45-degree field of view; 2212x1659.
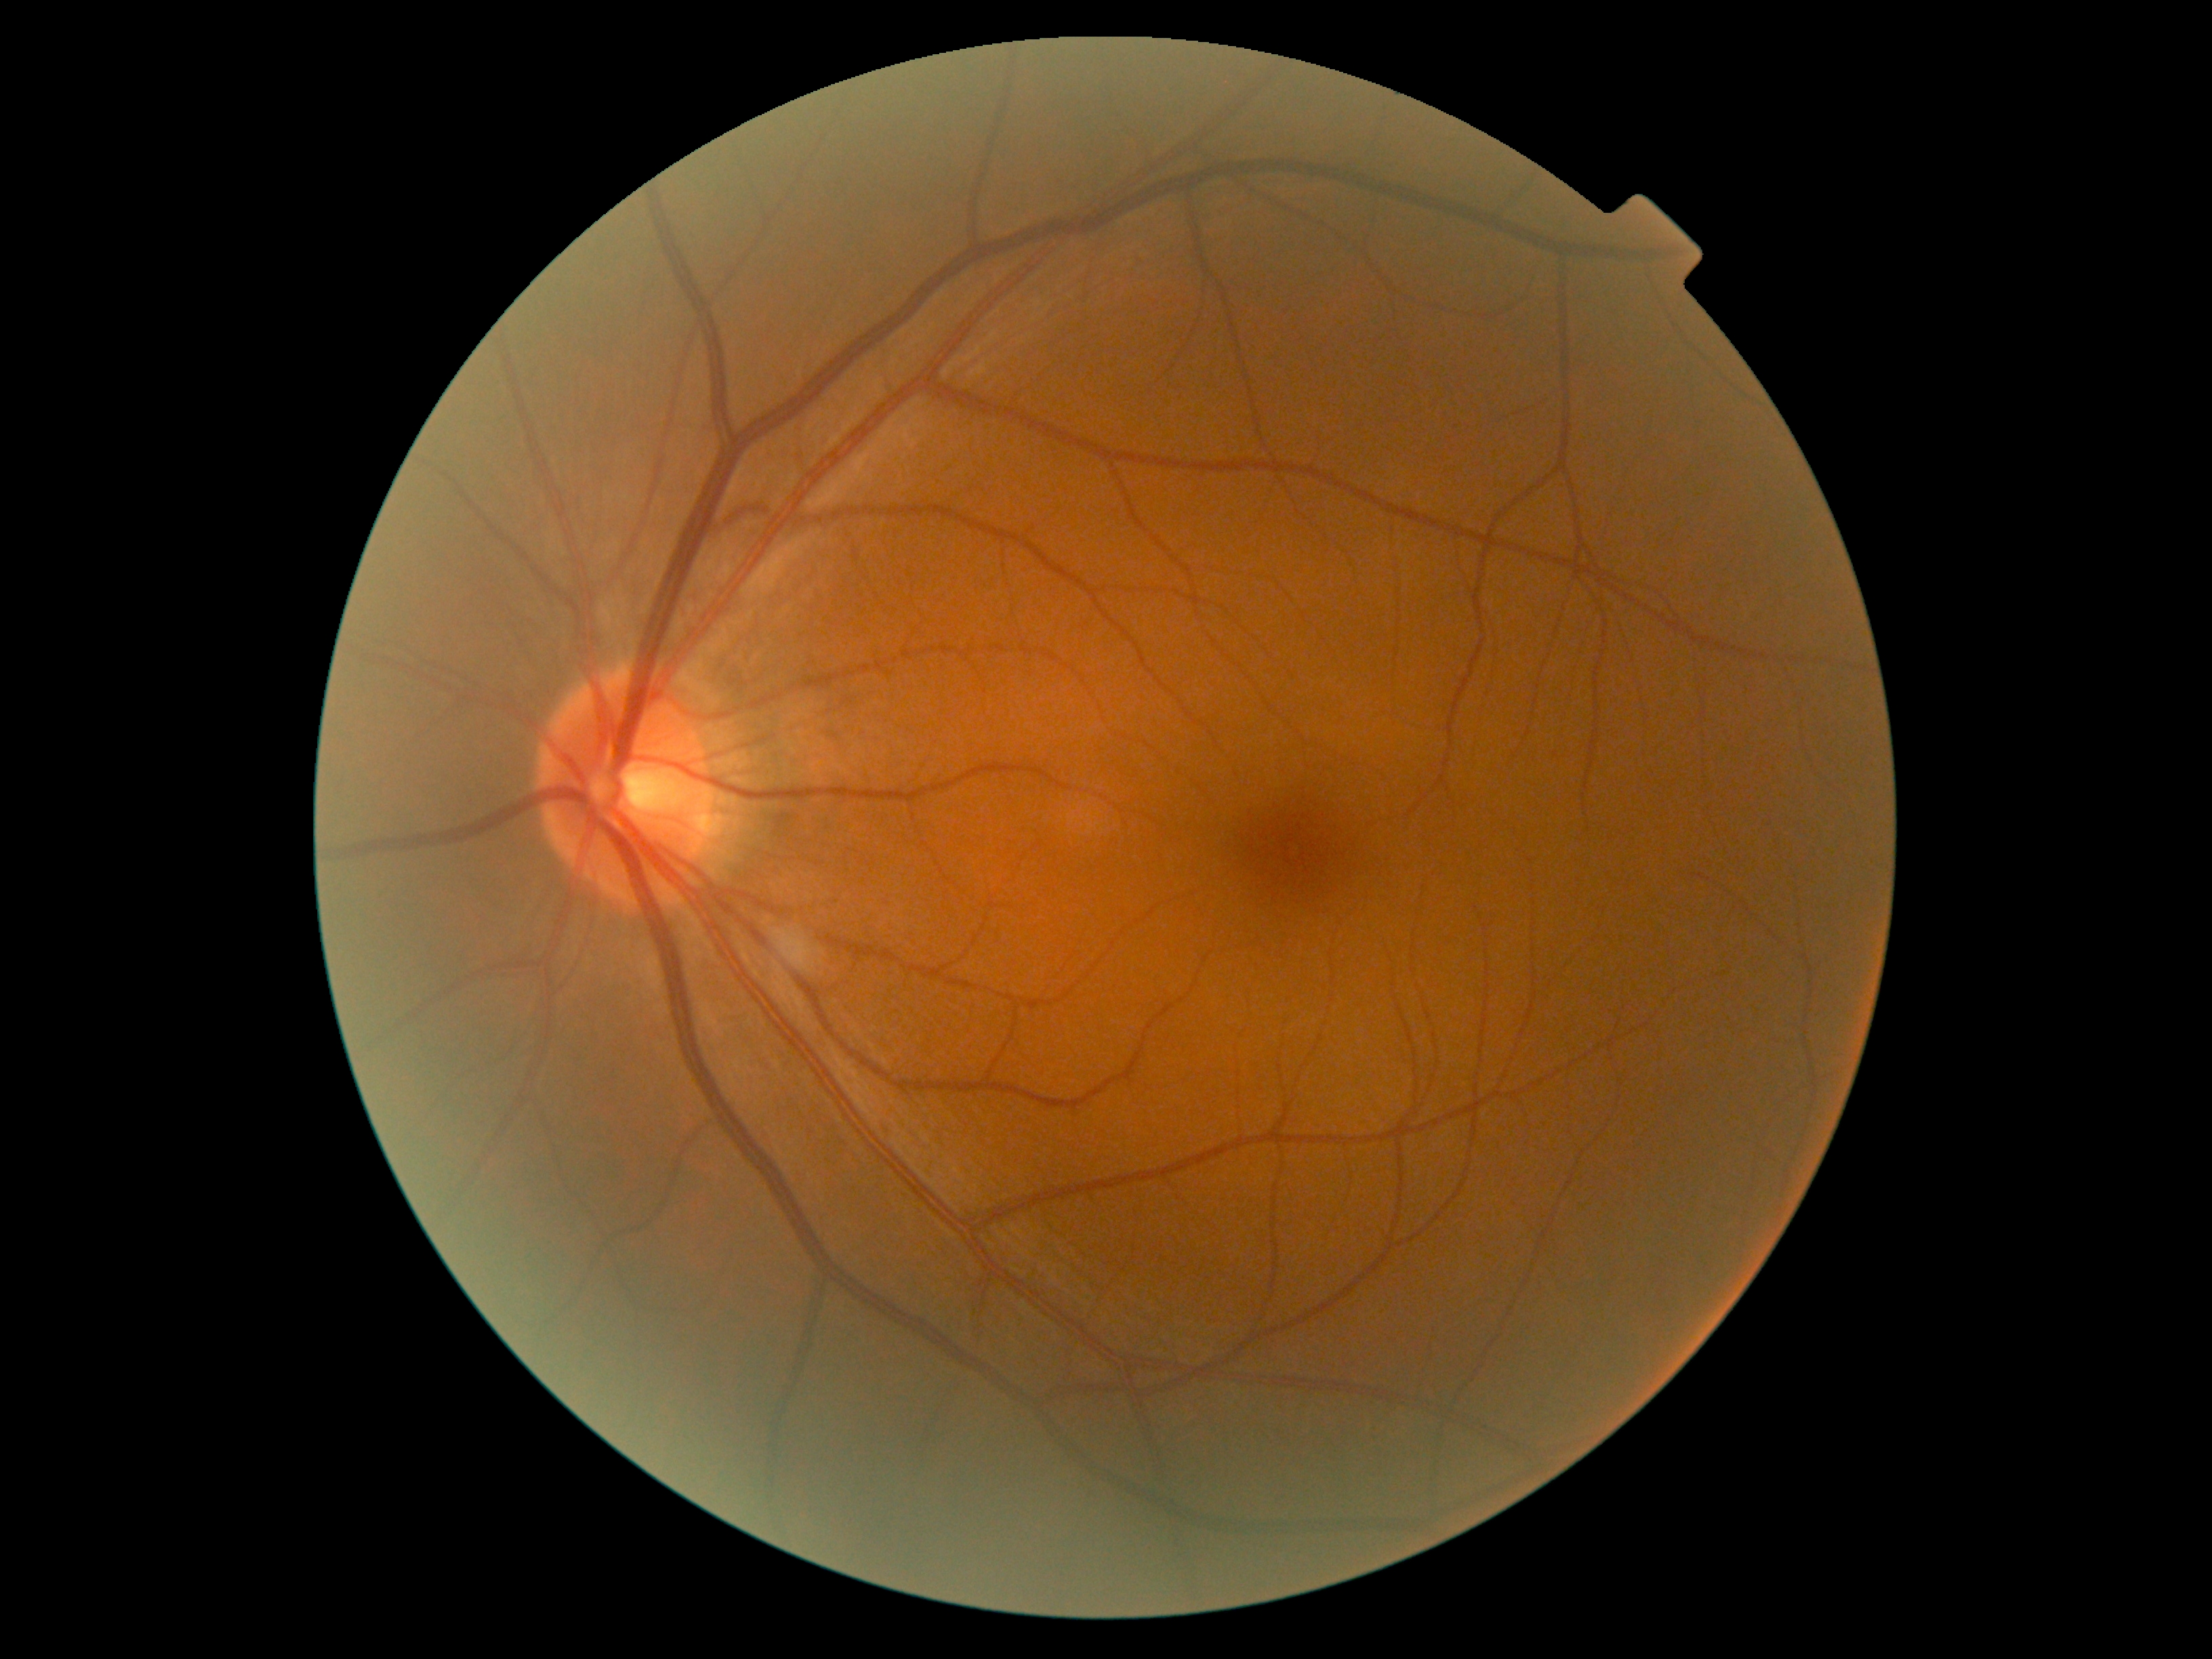

No DR findings.
Diabetic retinopathy grade: 0 (no apparent retinopathy).